Fundus photo
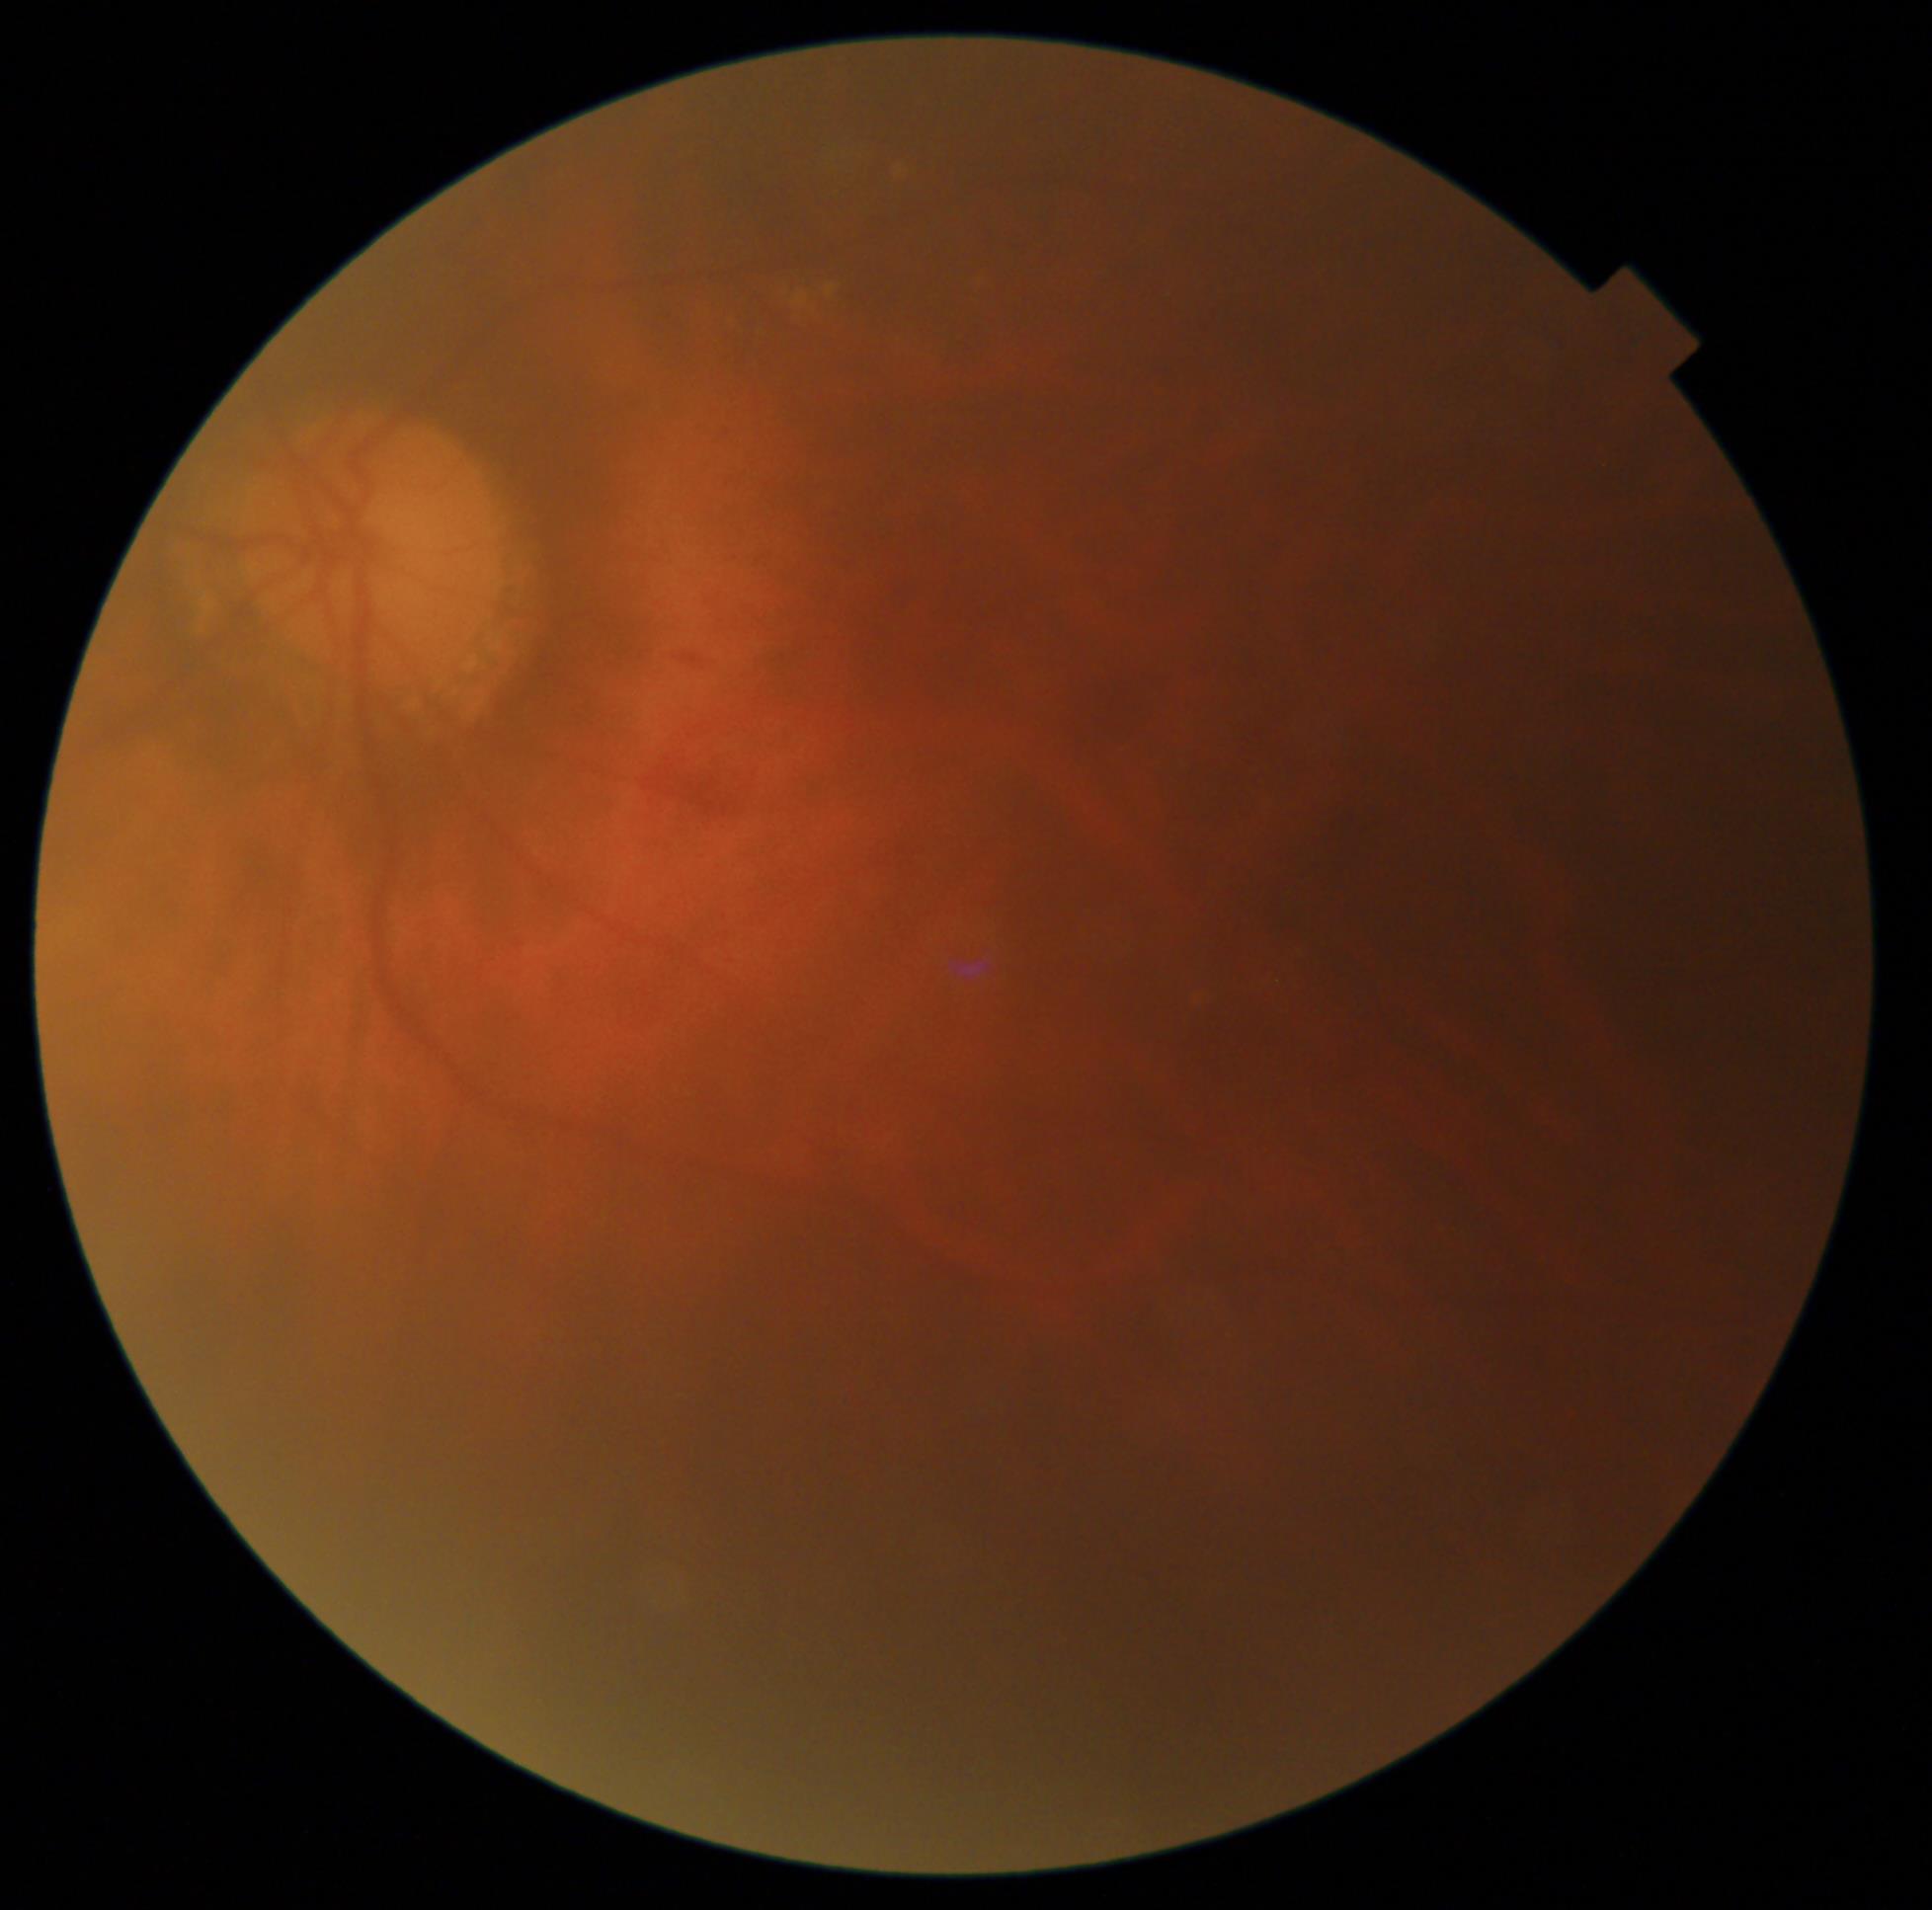

Annotations:
- retinopathy grade — moderate NPDR (2)